FOV: 45 degrees
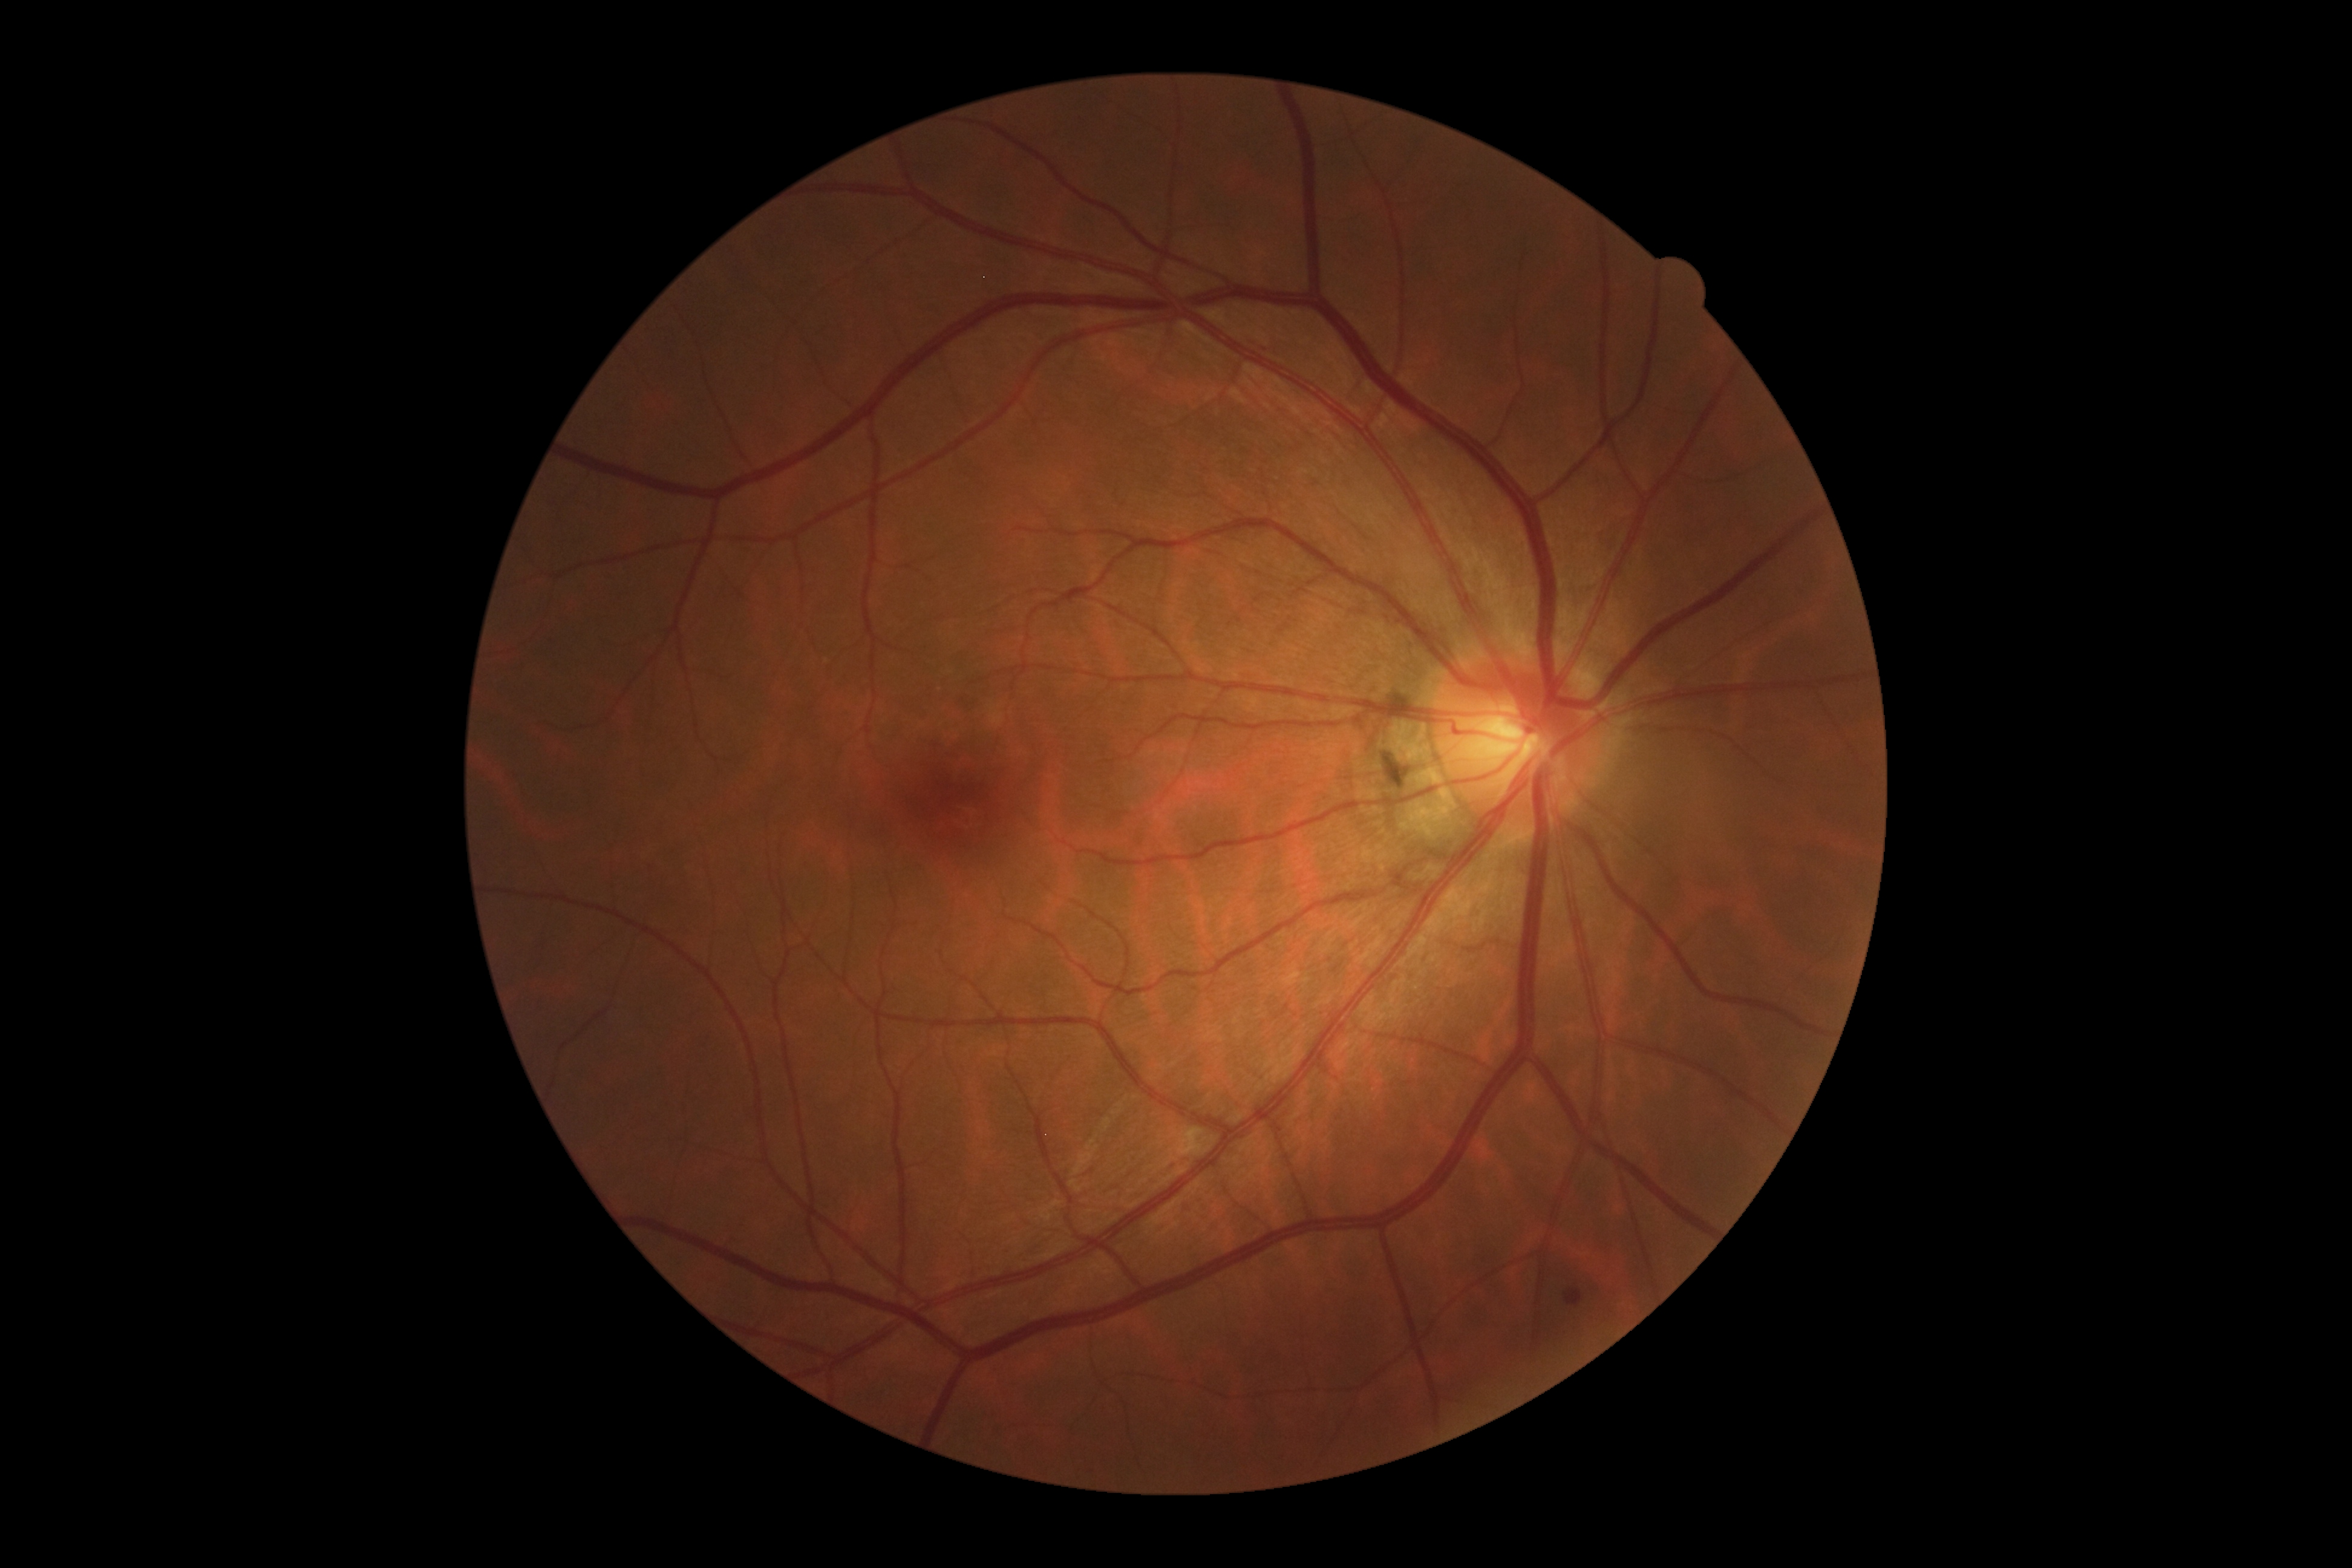 DR severity = grade 2, DR class = non-proliferative diabetic retinopathy.